Wide-field fundus photograph of an infant; 1240 by 1240 pixels
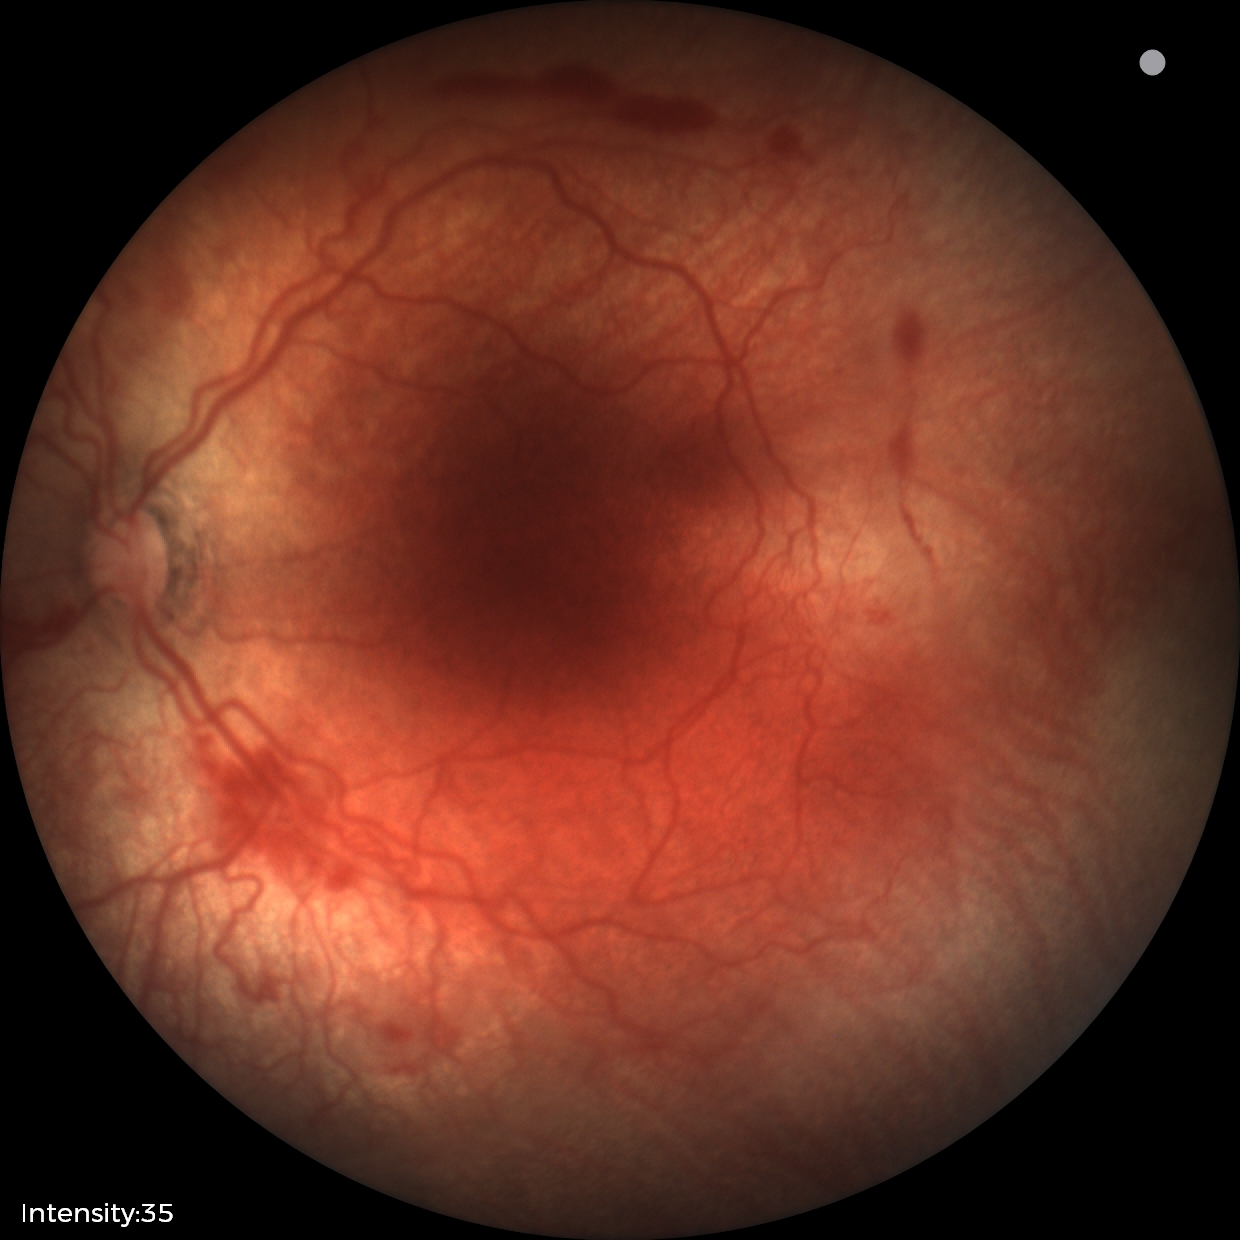 With plus disease. Examination diagnosed as ROP stage 2.